1659x2212px — 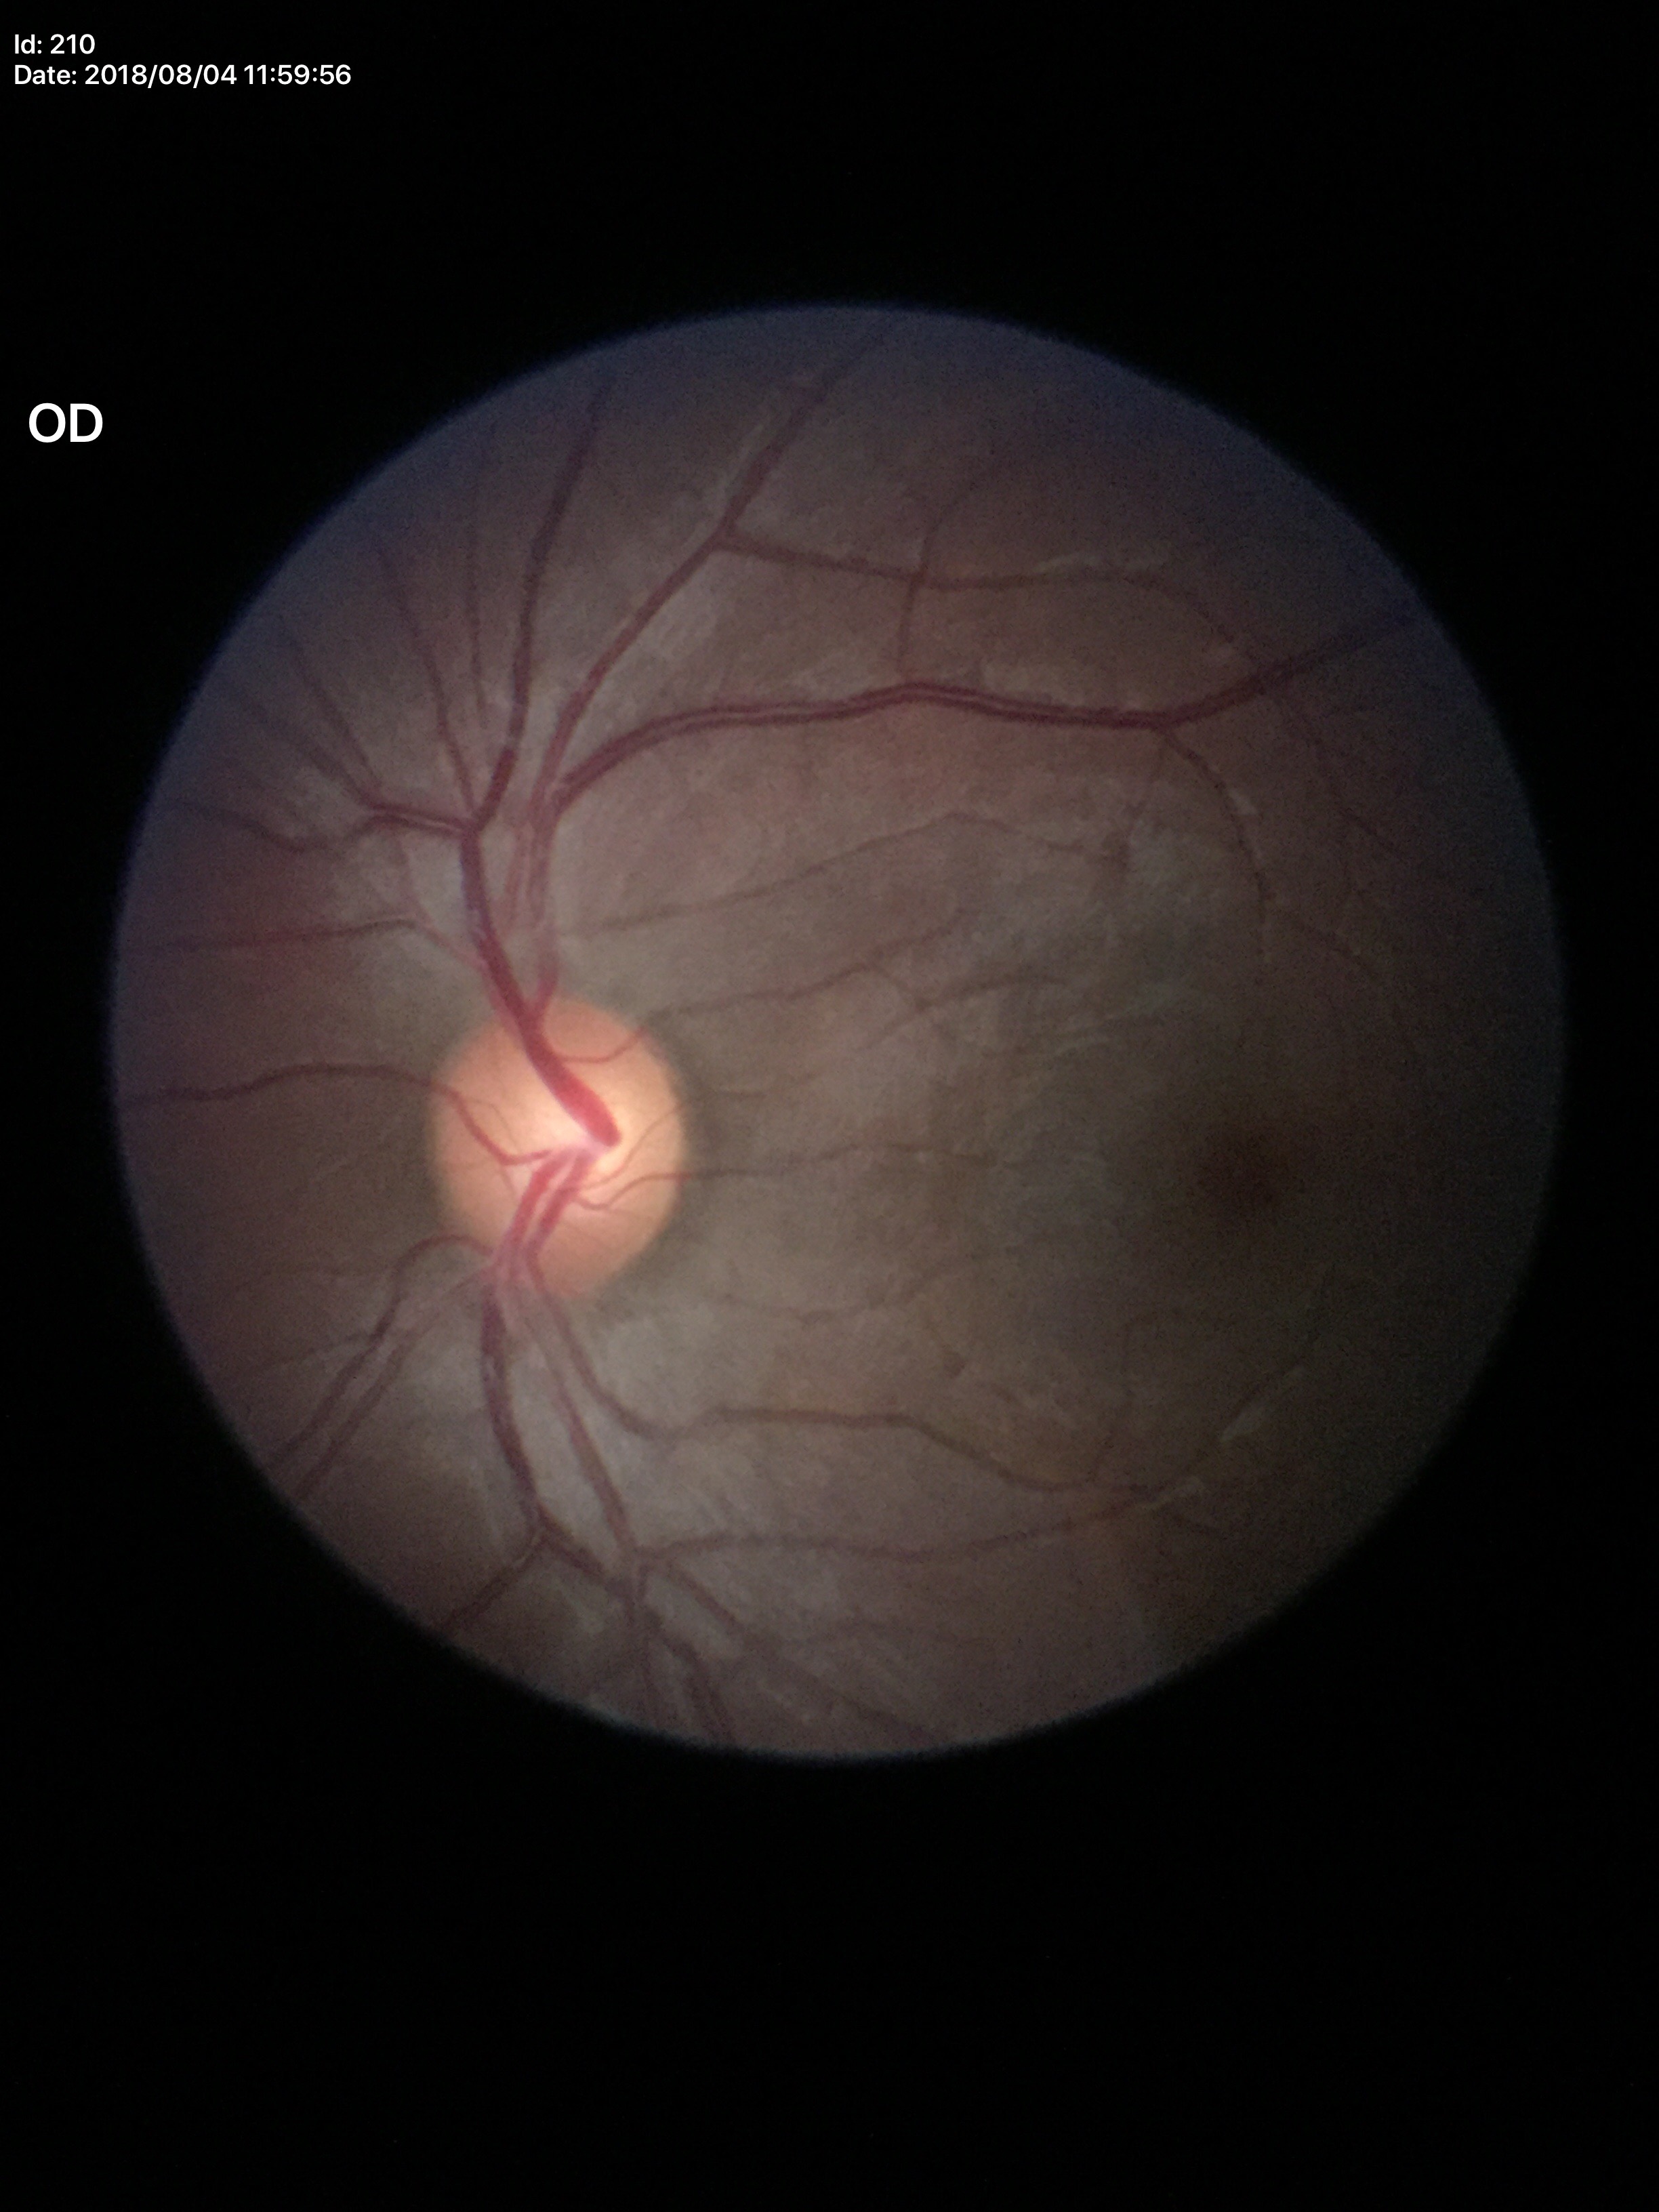 Q: What is the glaucoma assessment?
A: no suspicious findings (one of five ophthalmologists flagged glaucoma suspect)
Q: What is the vertical cup-to-disc ratio?
A: 0.57